Diabetic retinopathy graded by the modified Davis classification:
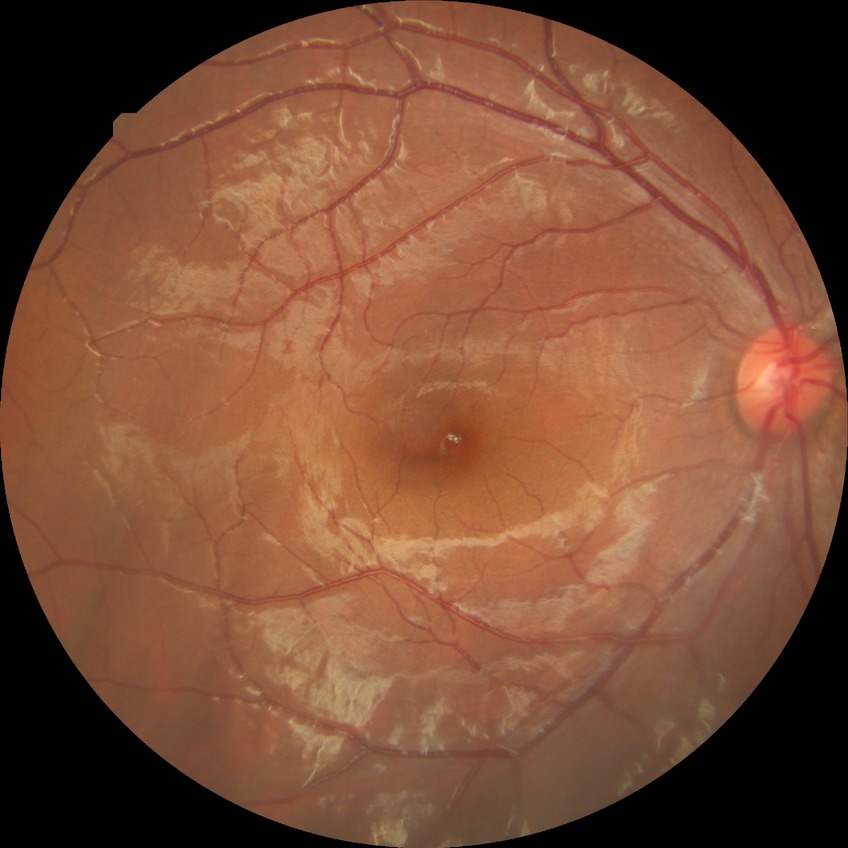
Diabetic retinopathy (DR): no diabetic retinopathy (NDR).